DR severity per modified Davis staging.
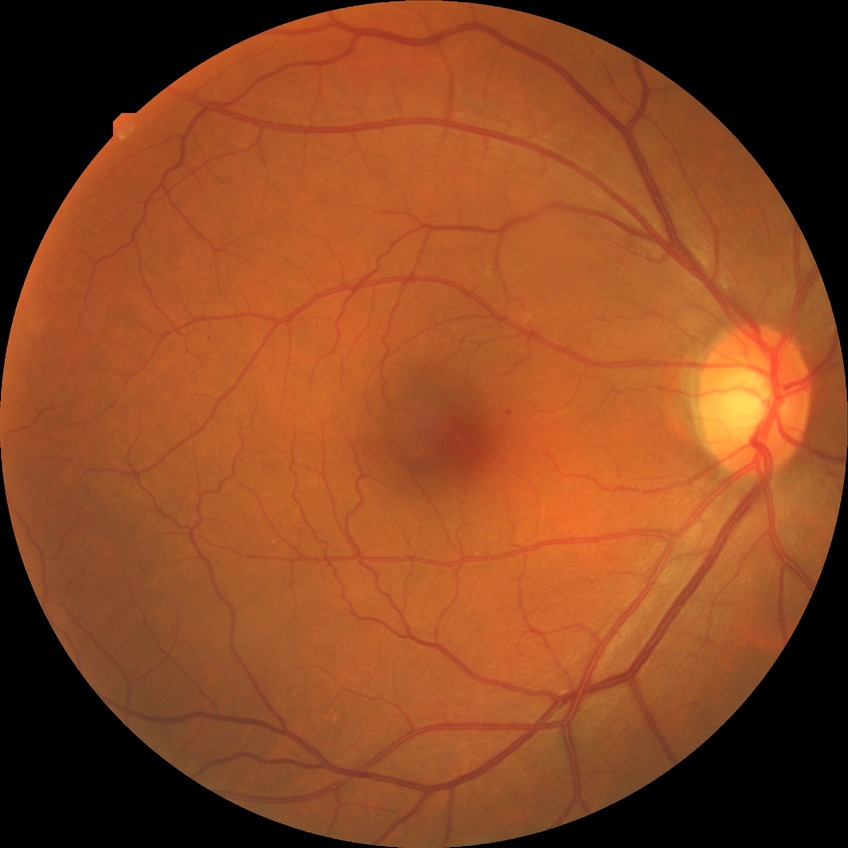

modified Davis grading@no diabetic retinopathy.